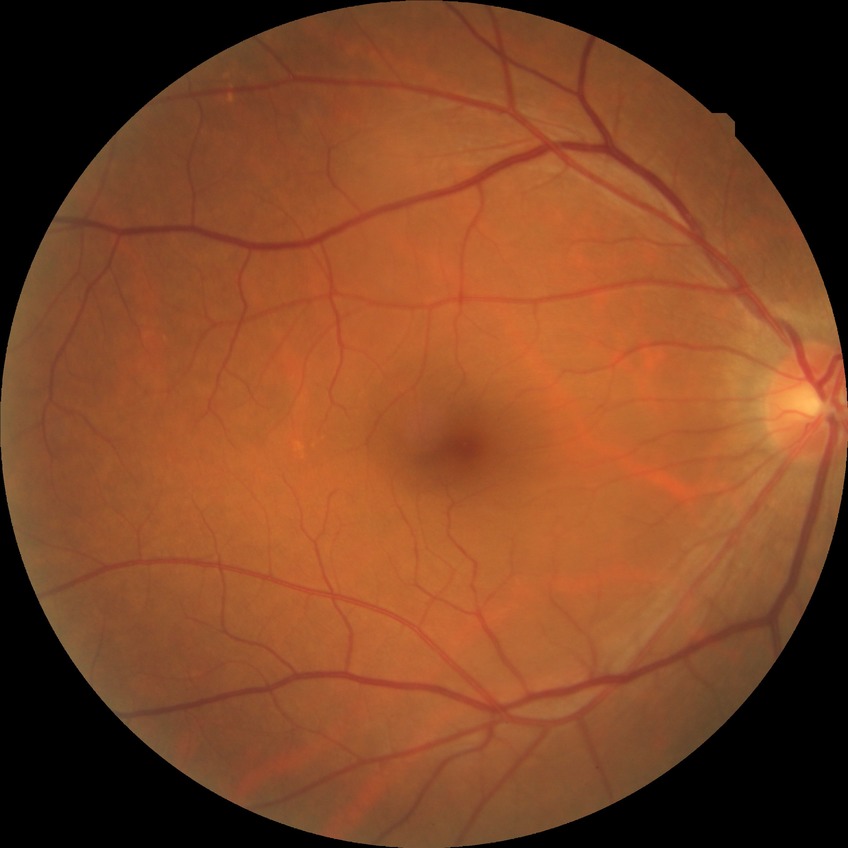

Diabetic retinopathy (DR) is no diabetic retinopathy (NDR).